2346 x 1568 pixels; 45° FOV.
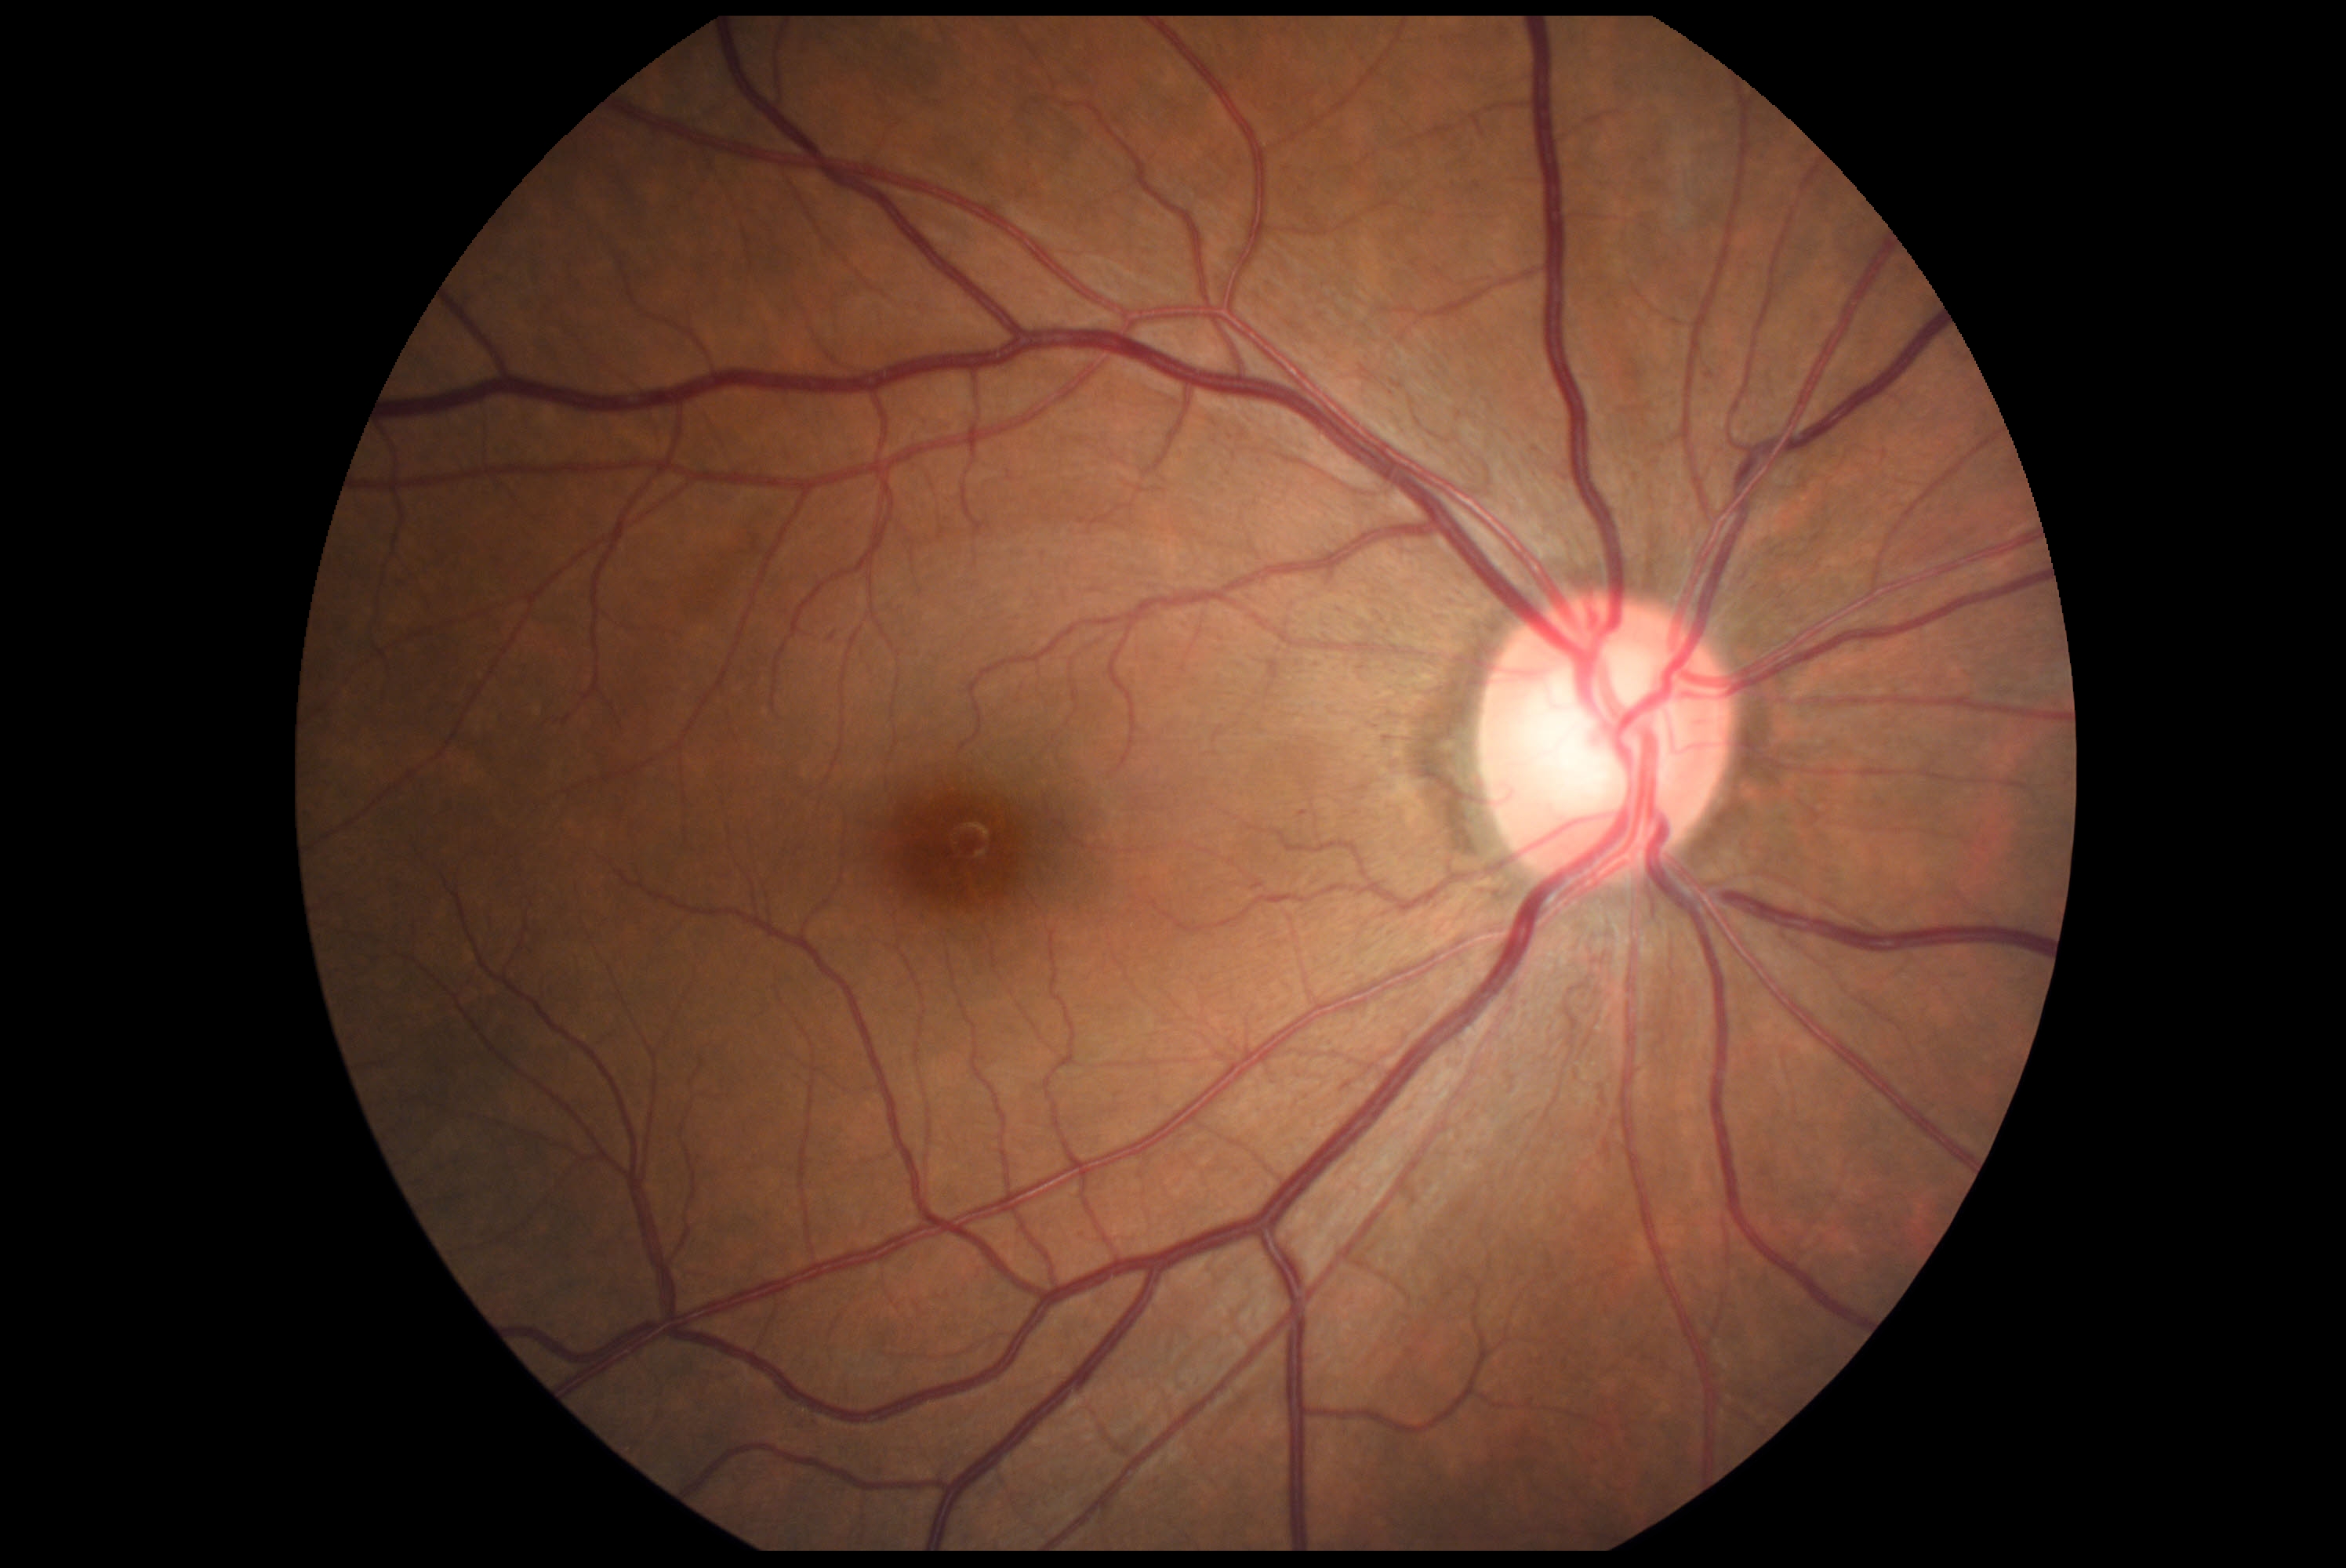
dr_grade: grade 0